Nonmydriatic fundus photograph; NIDEK AFC-230 fundus camera
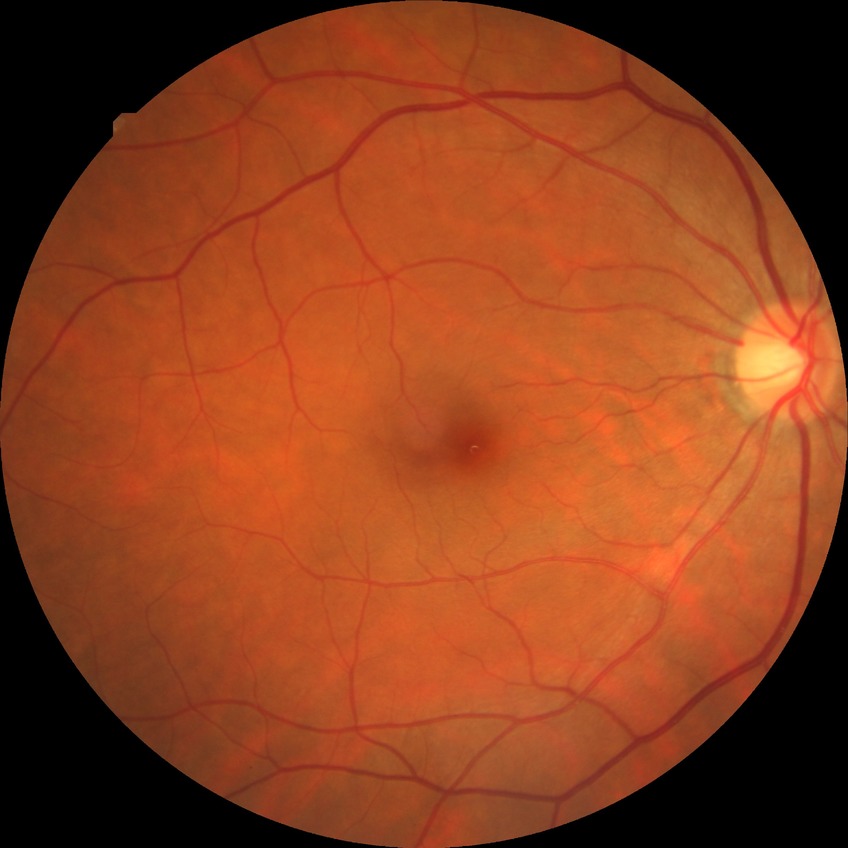 Davis DR grade is NDR.